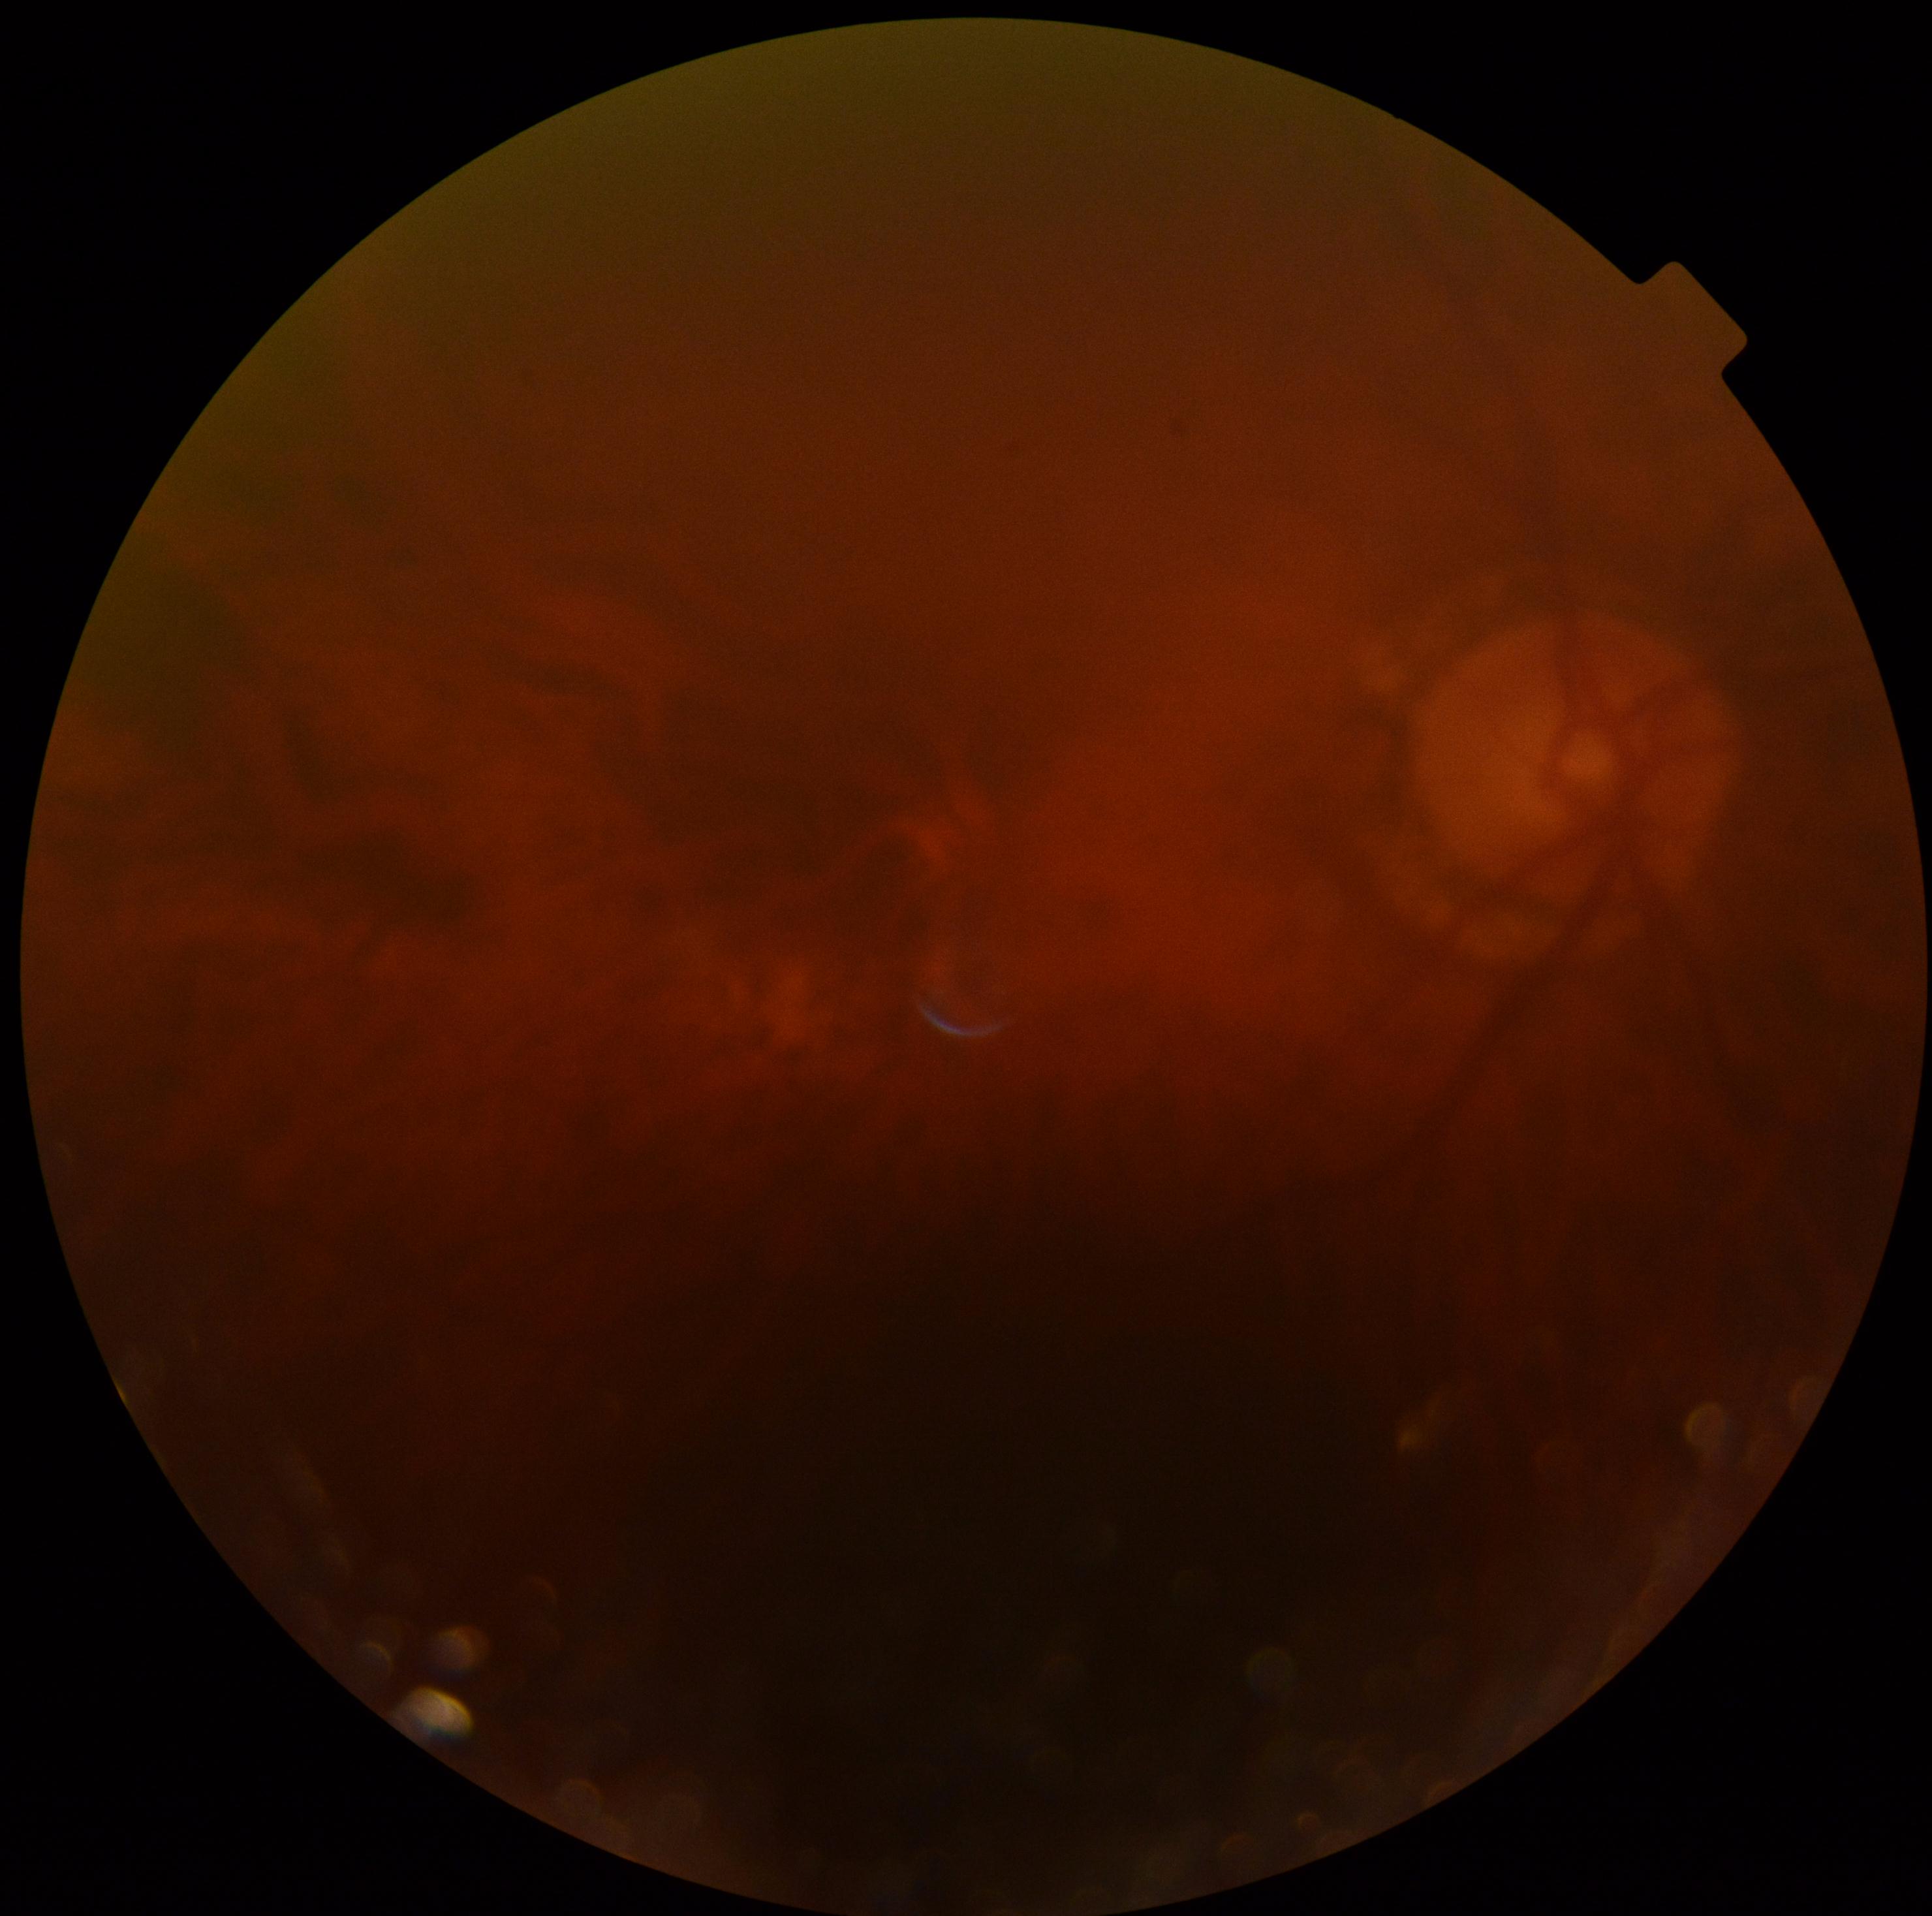 DR: grade 0 — no visible signs of diabetic retinopathy.